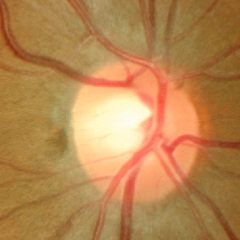

Q: What stage of glaucoma is present?
A: No glaucoma.